Modified Davis classification: 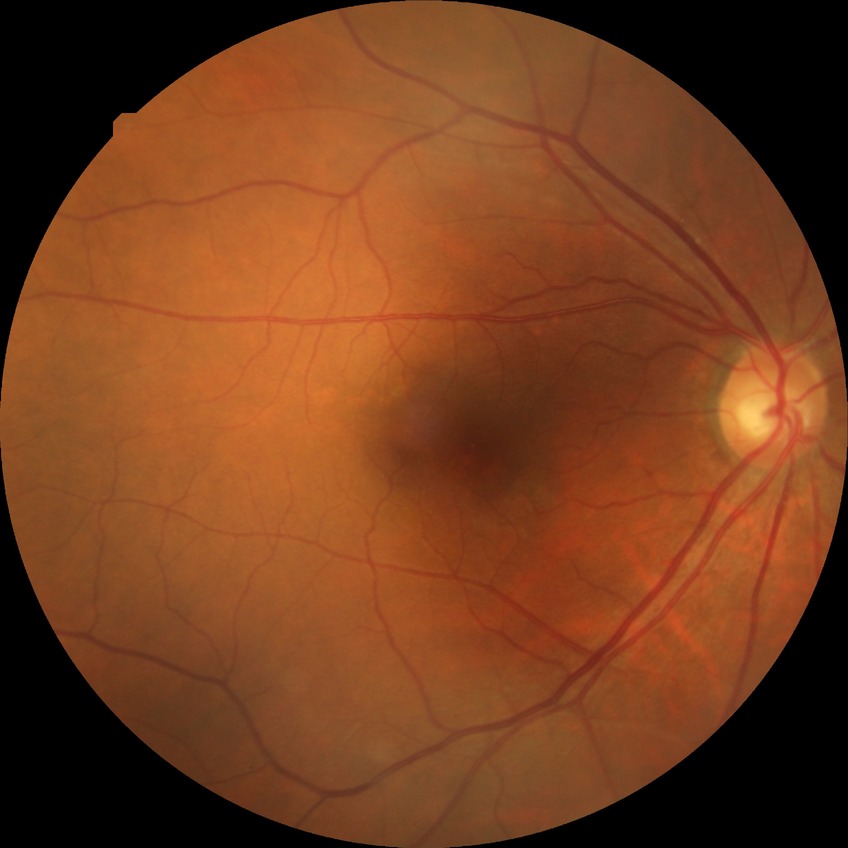

diabetic retinopathy severity: no diabetic retinopathy.